Infant wide-field fundus photograph. Captured with the Phoenix ICON (100° field of view). 1240x1240px.
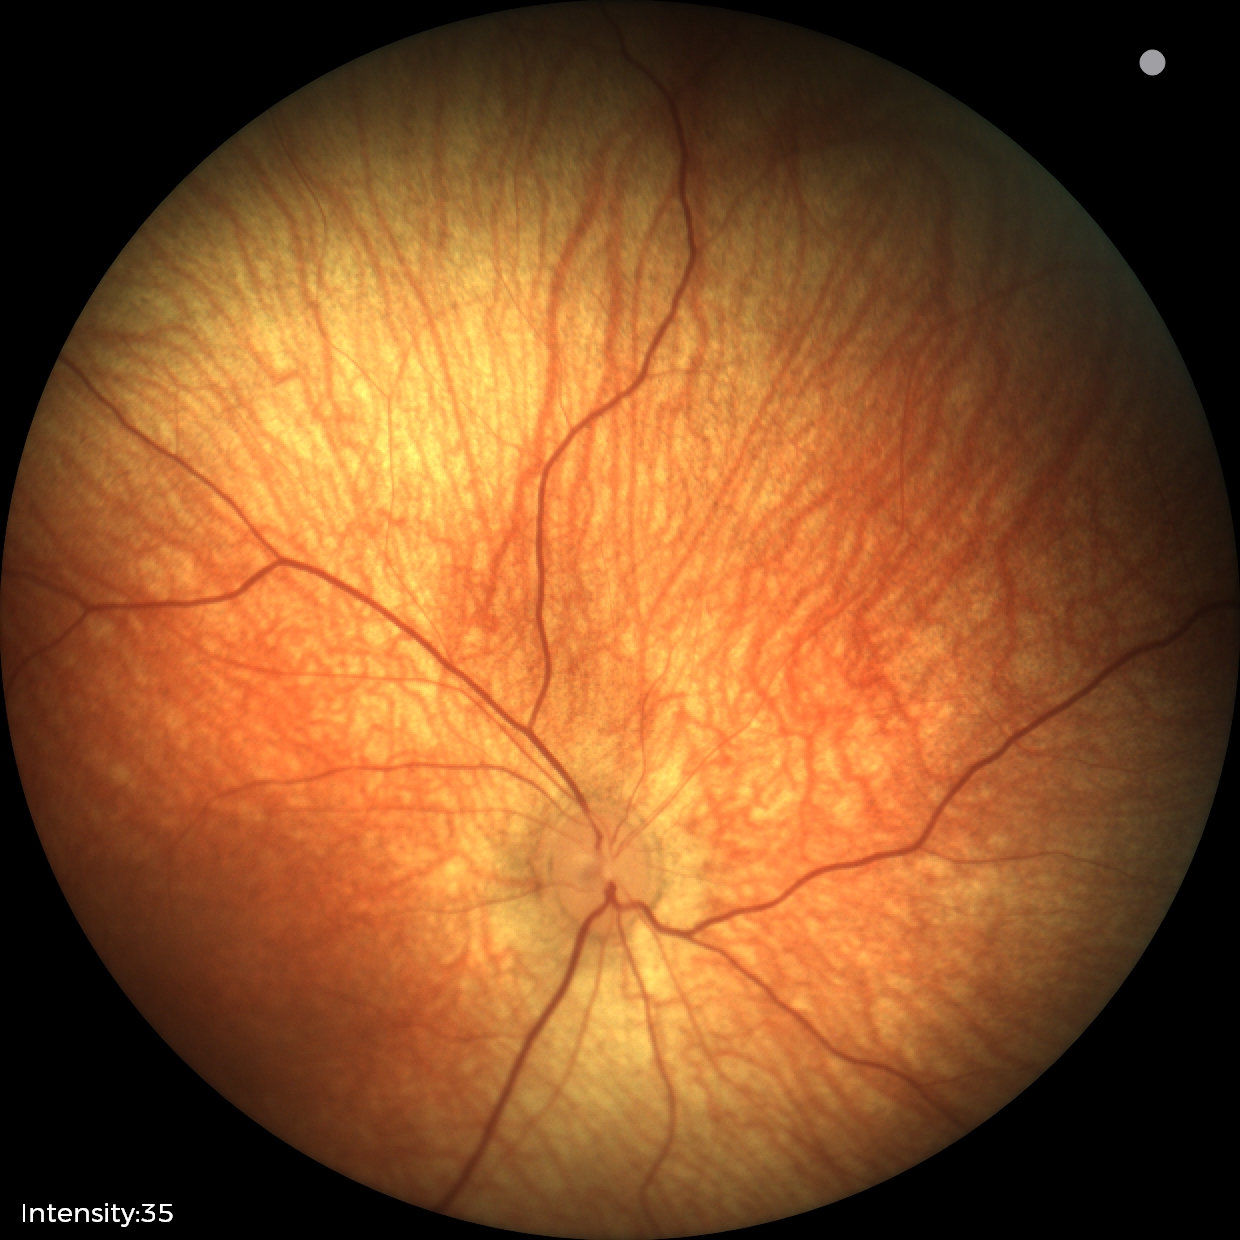
Examination with physiological retinal findings.